Fundus photo; FOV: 45 degrees:
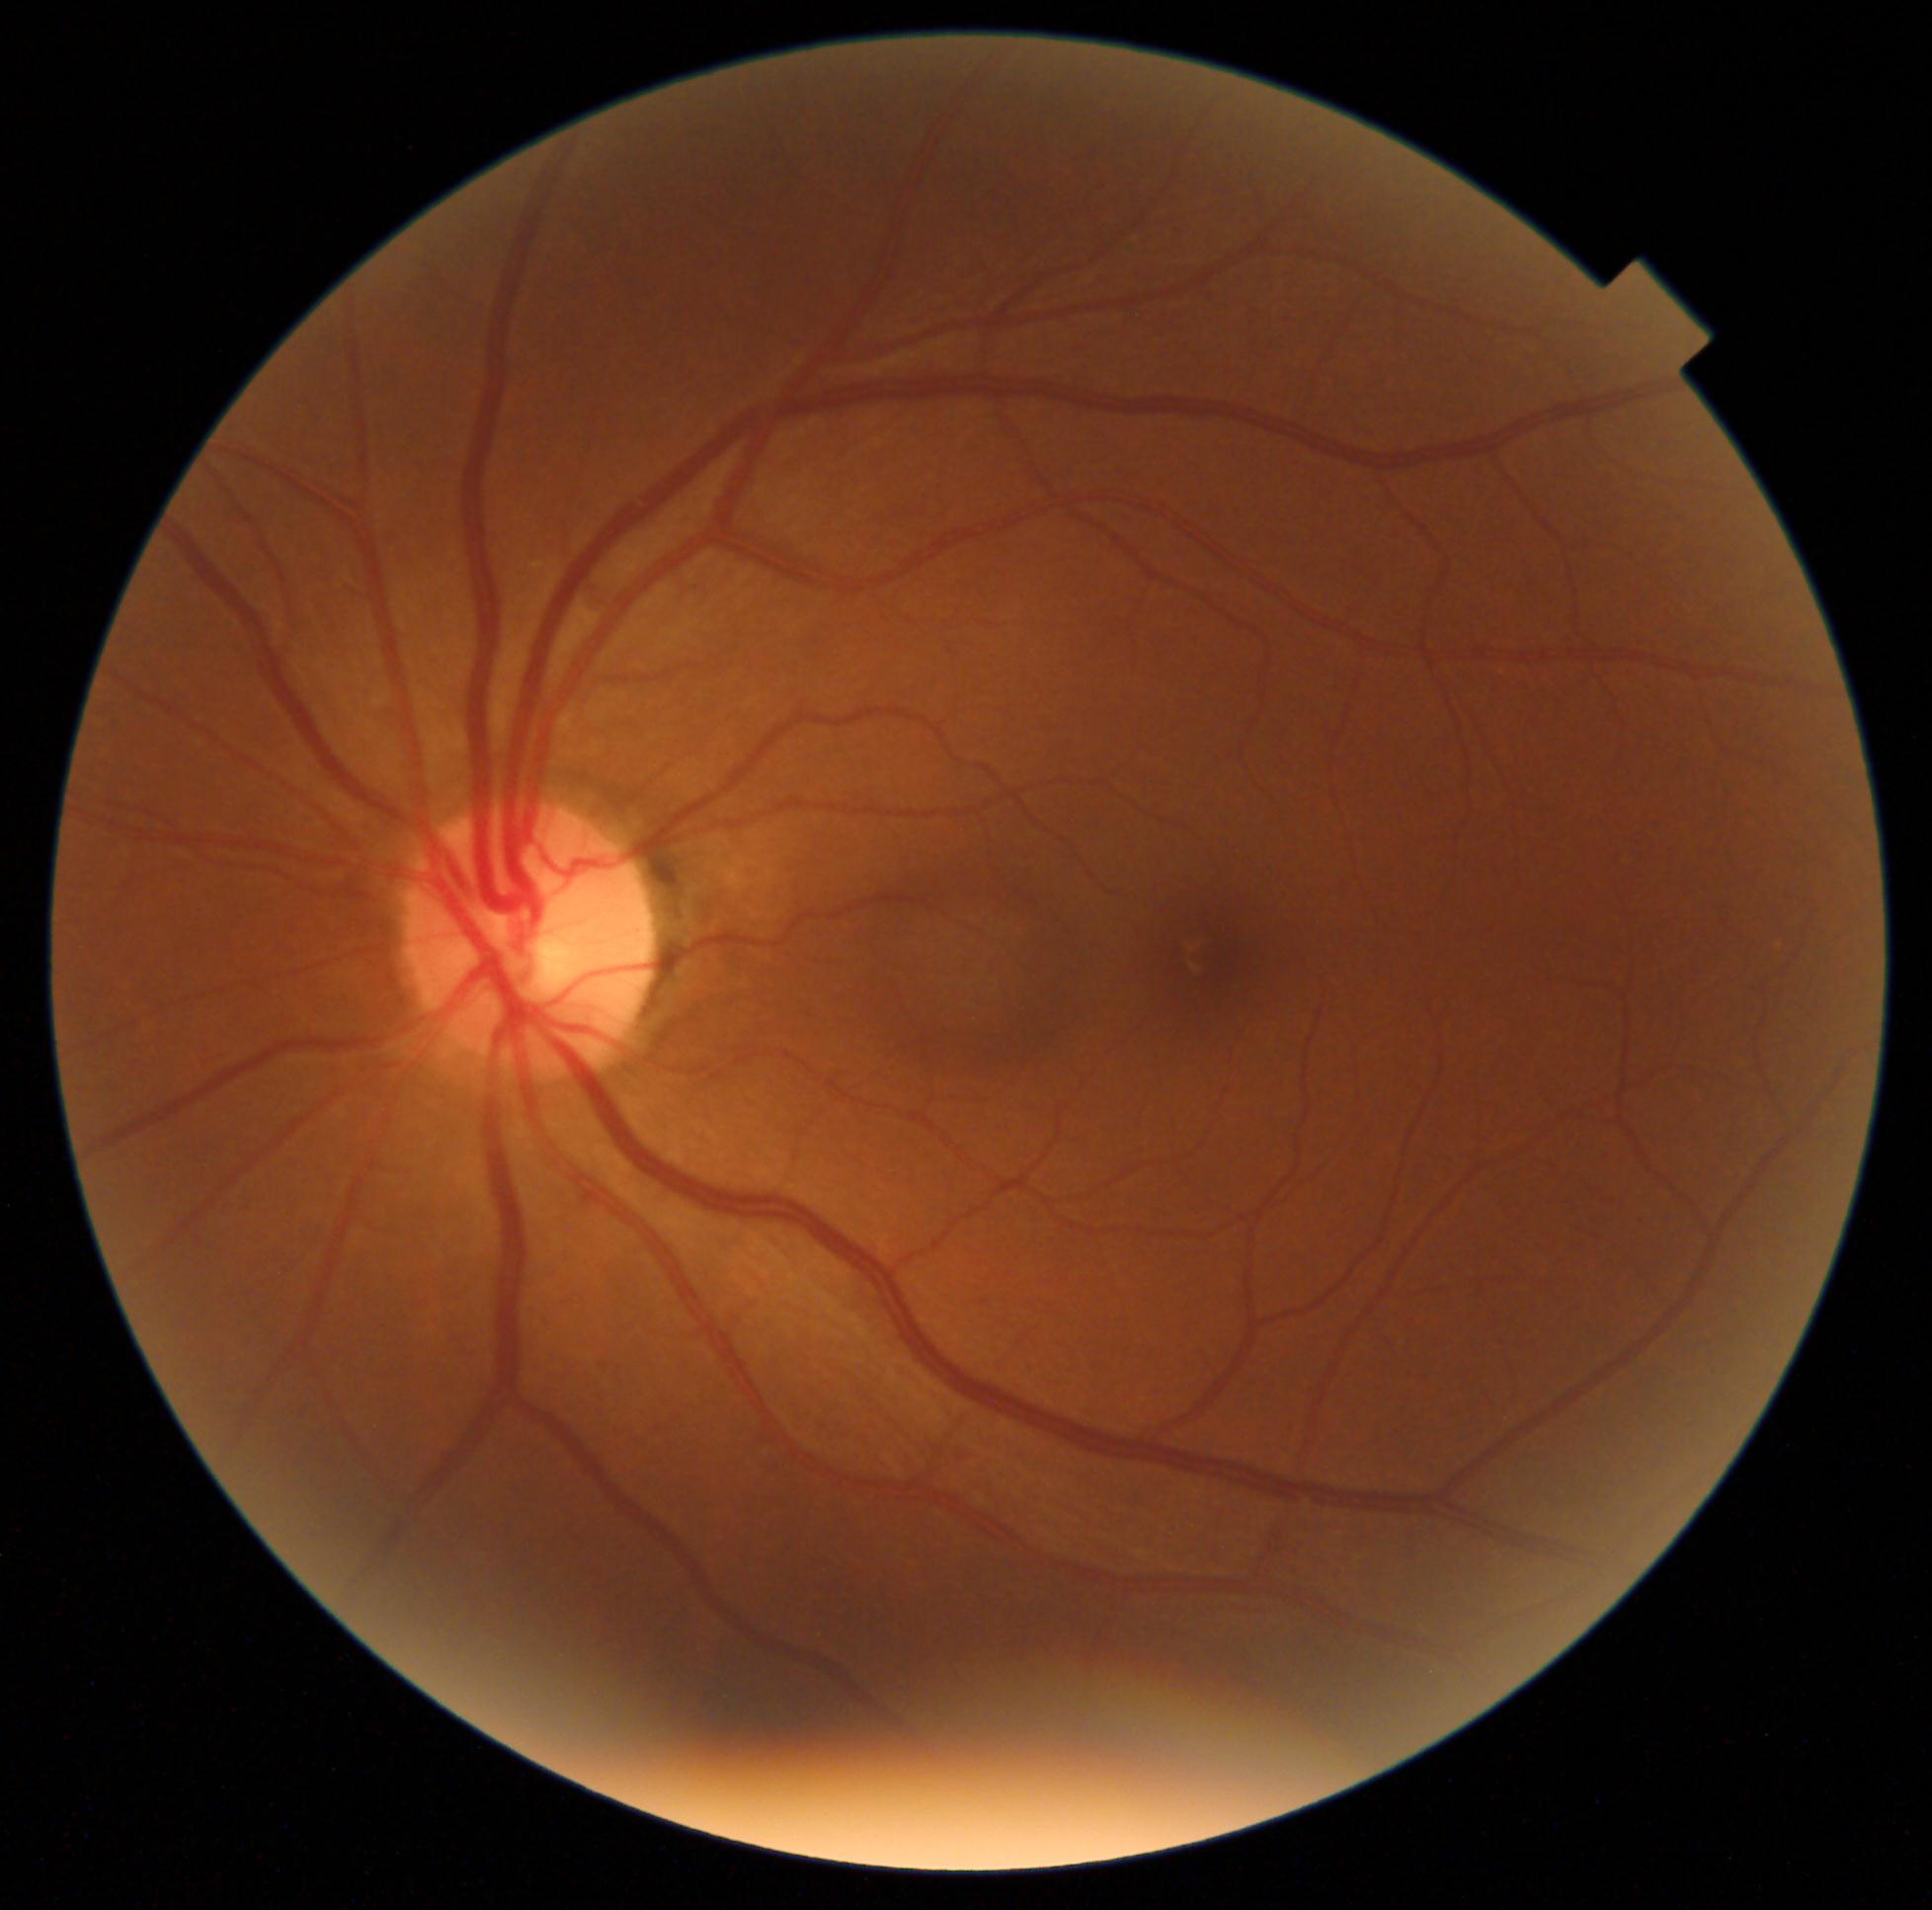
DR impression = no apparent DR; diabetic retinopathy = no apparent diabetic retinopathy (grade 0).